NIDEK AFC-230 fundus camera · image size 848x848 · no pharmacologic dilation: 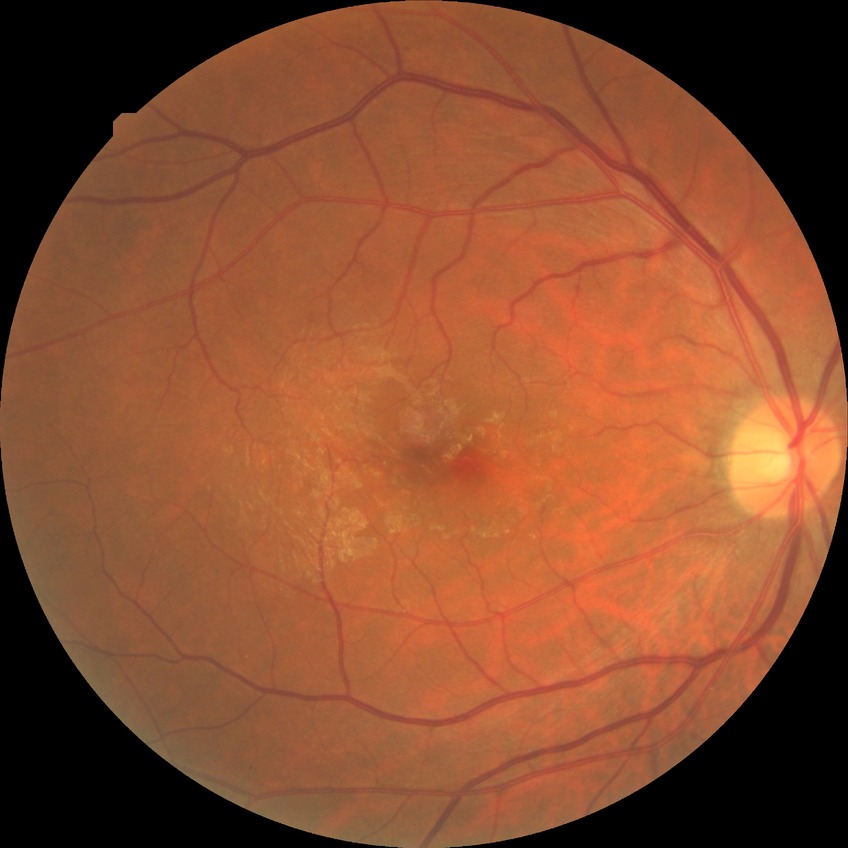
diabetic retinopathy stage = no diabetic retinopathy.